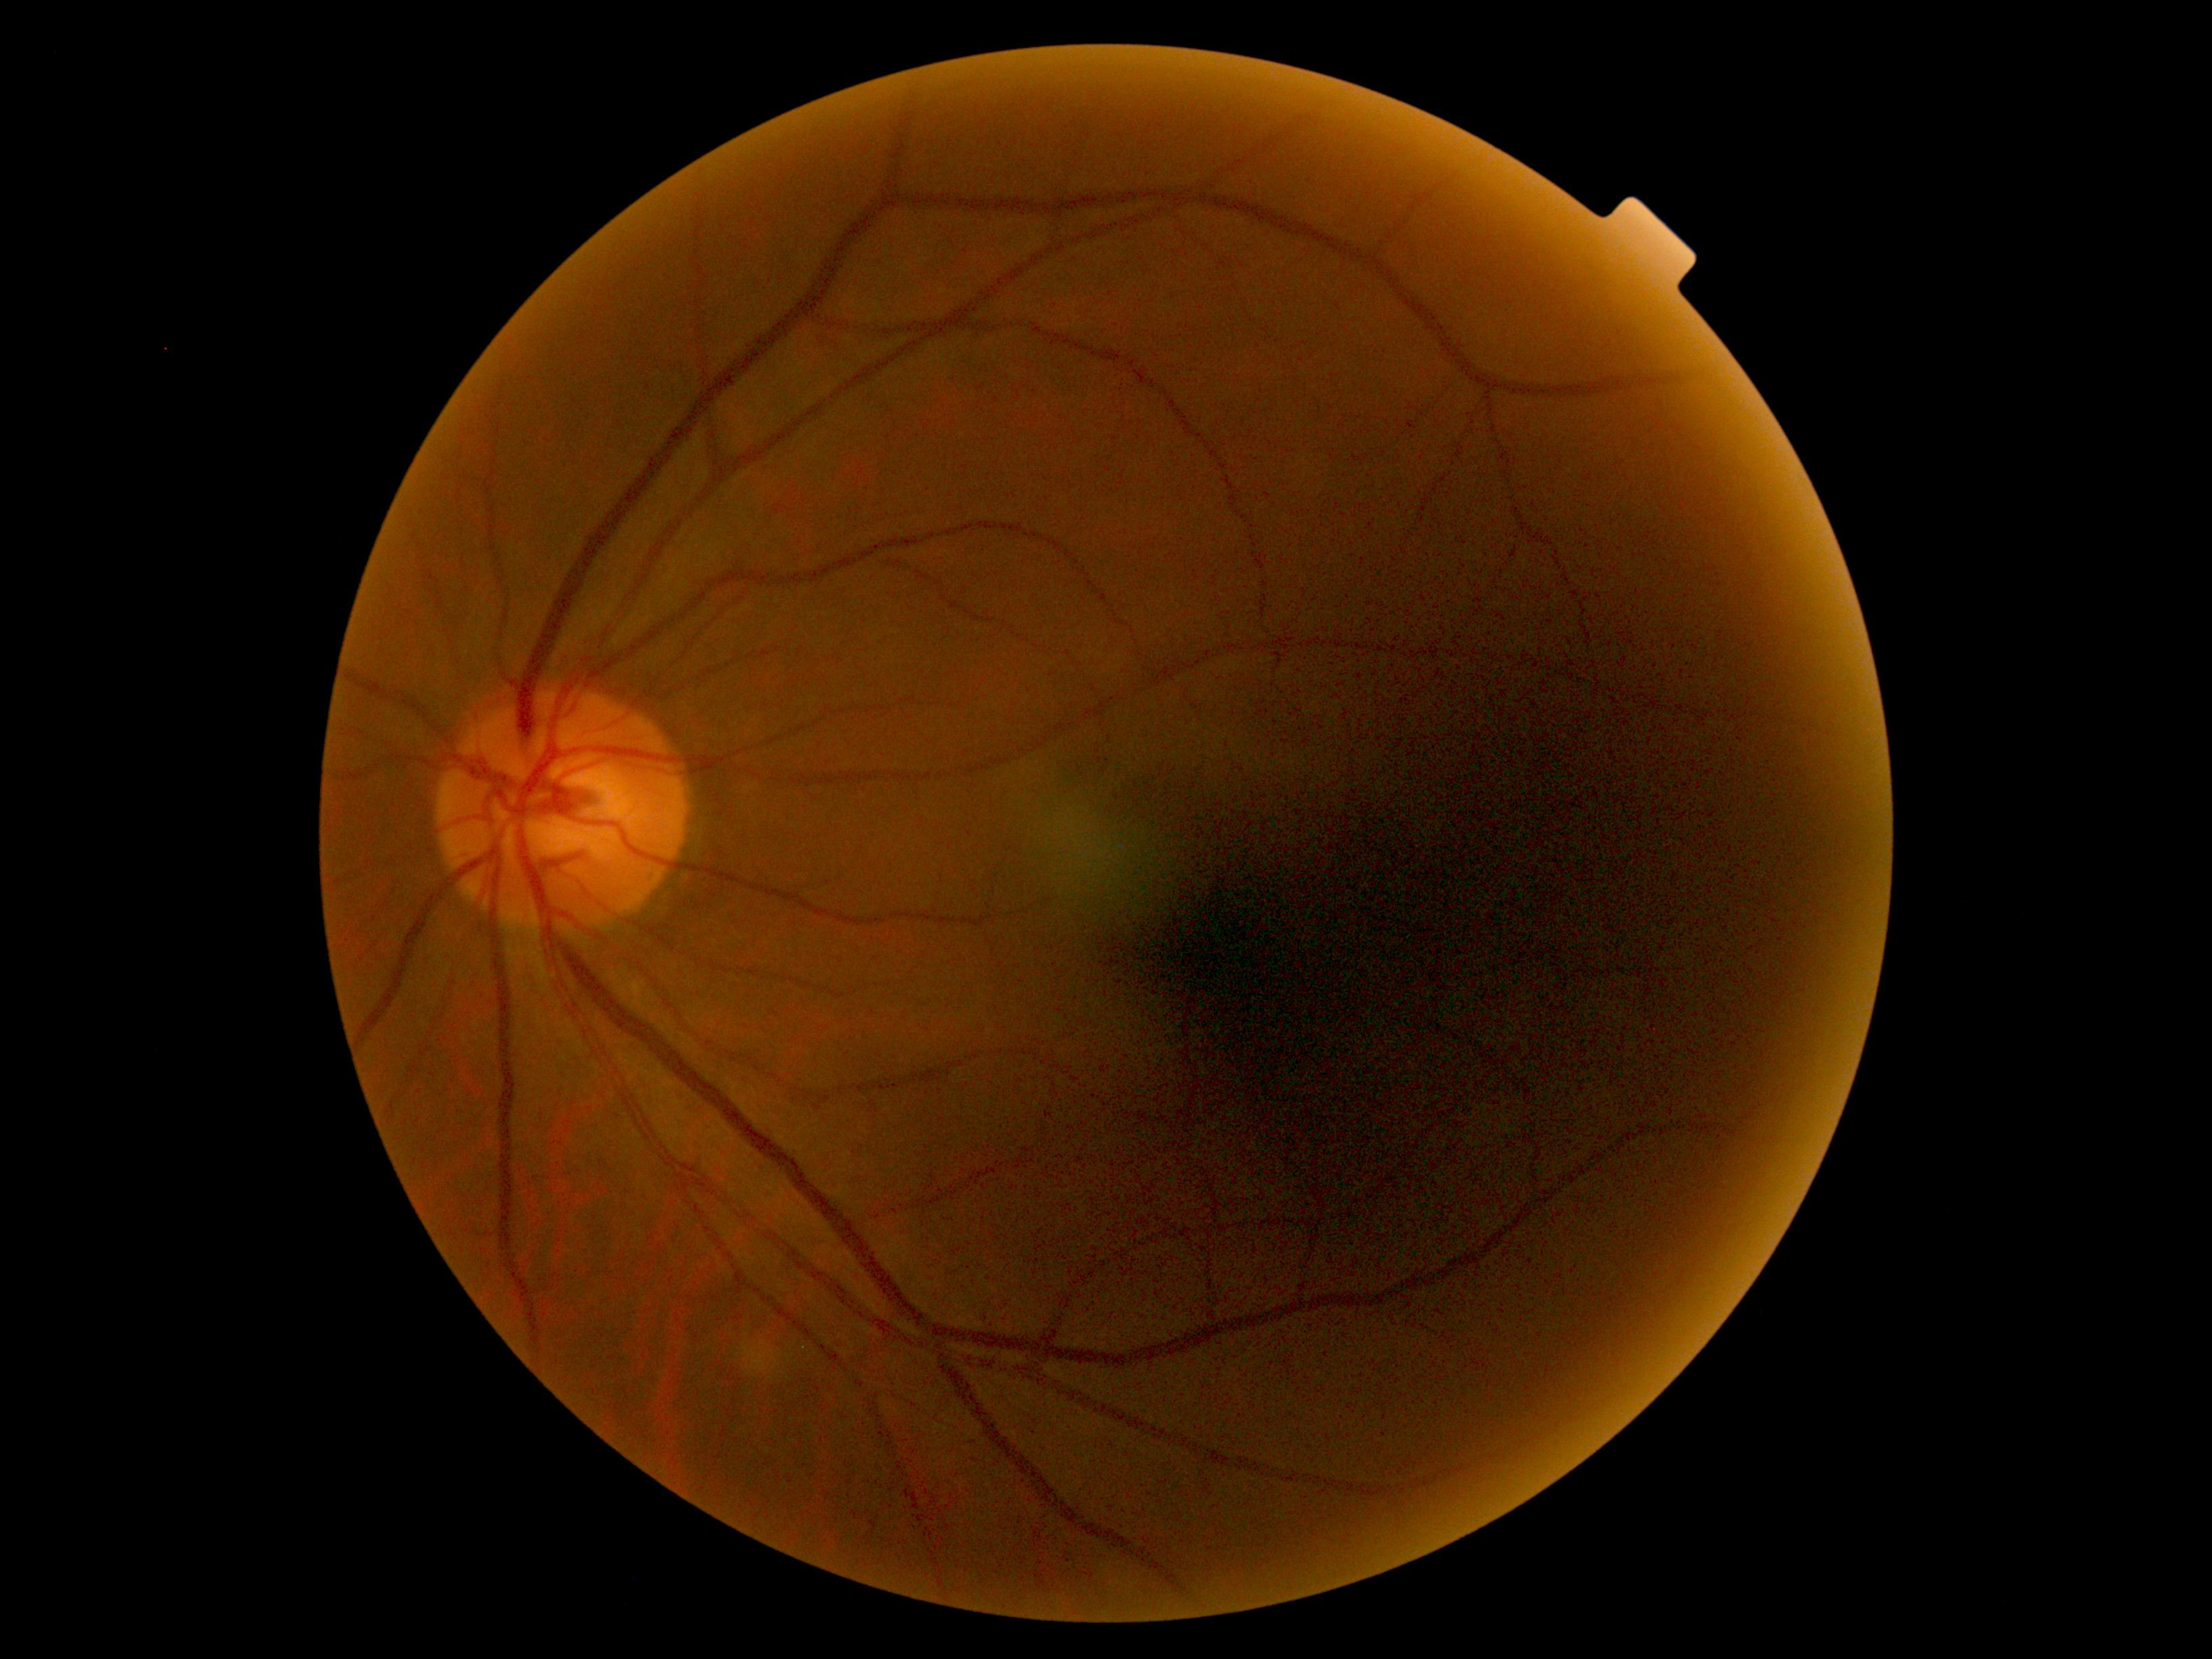 DR stage = grade 0 (no apparent retinopathy) — no visible signs of diabetic retinopathy; DR impression = no DR findings.